Infant wide-field retinal image. 1440x1080: 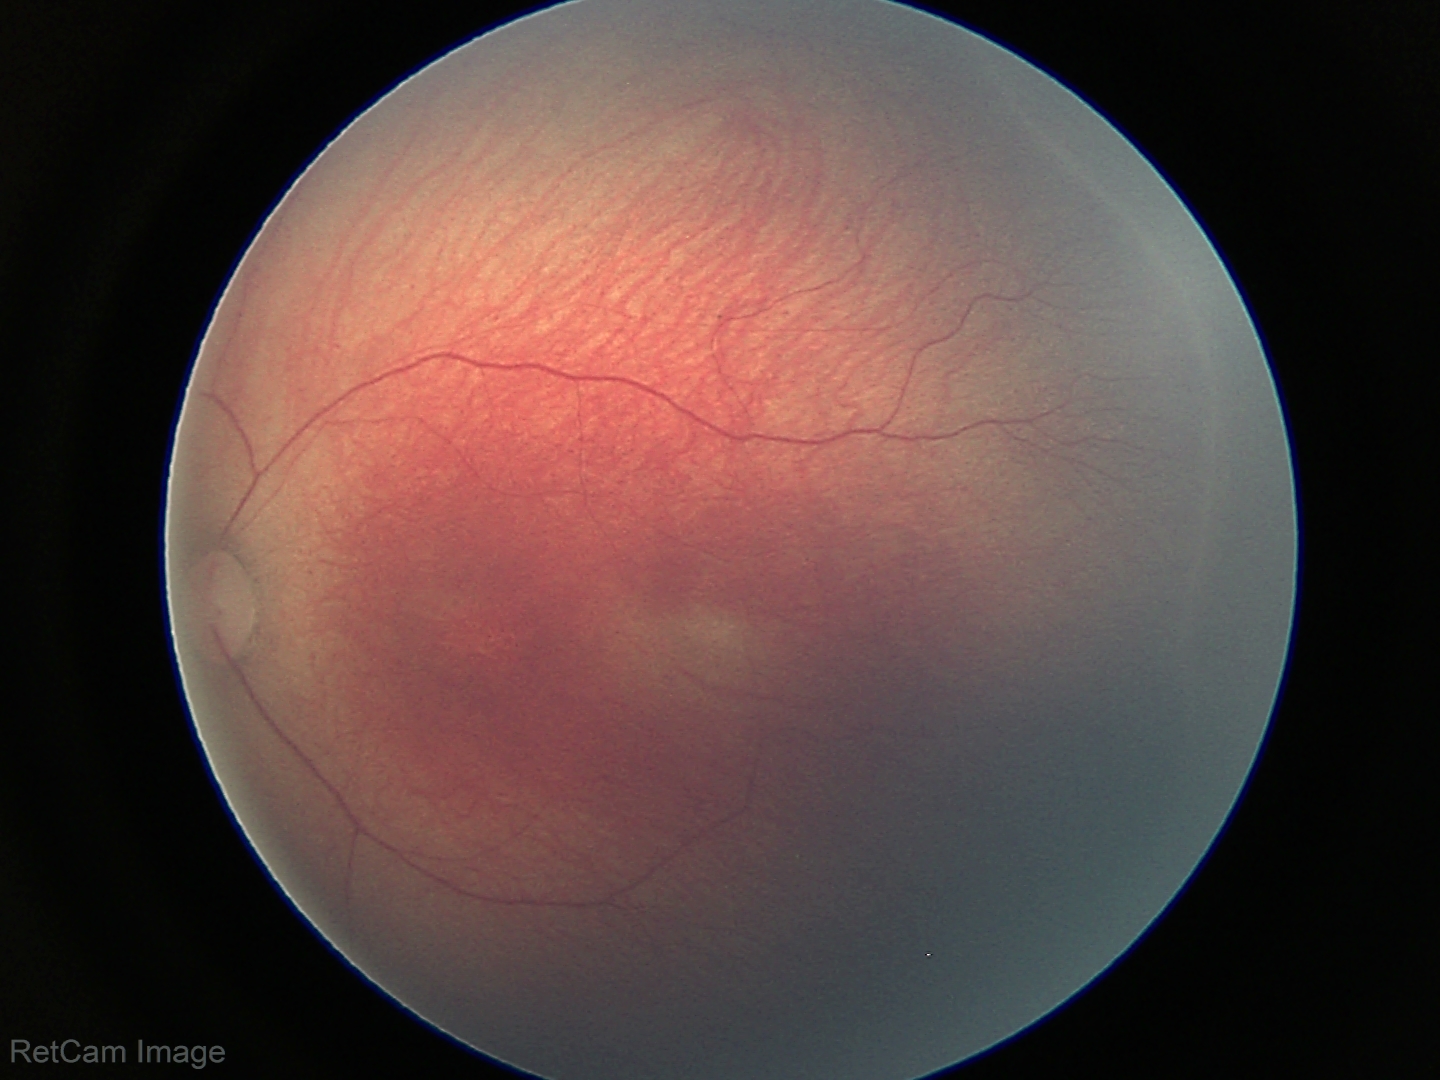

From an examination with diagnosis of ROP stage 2.